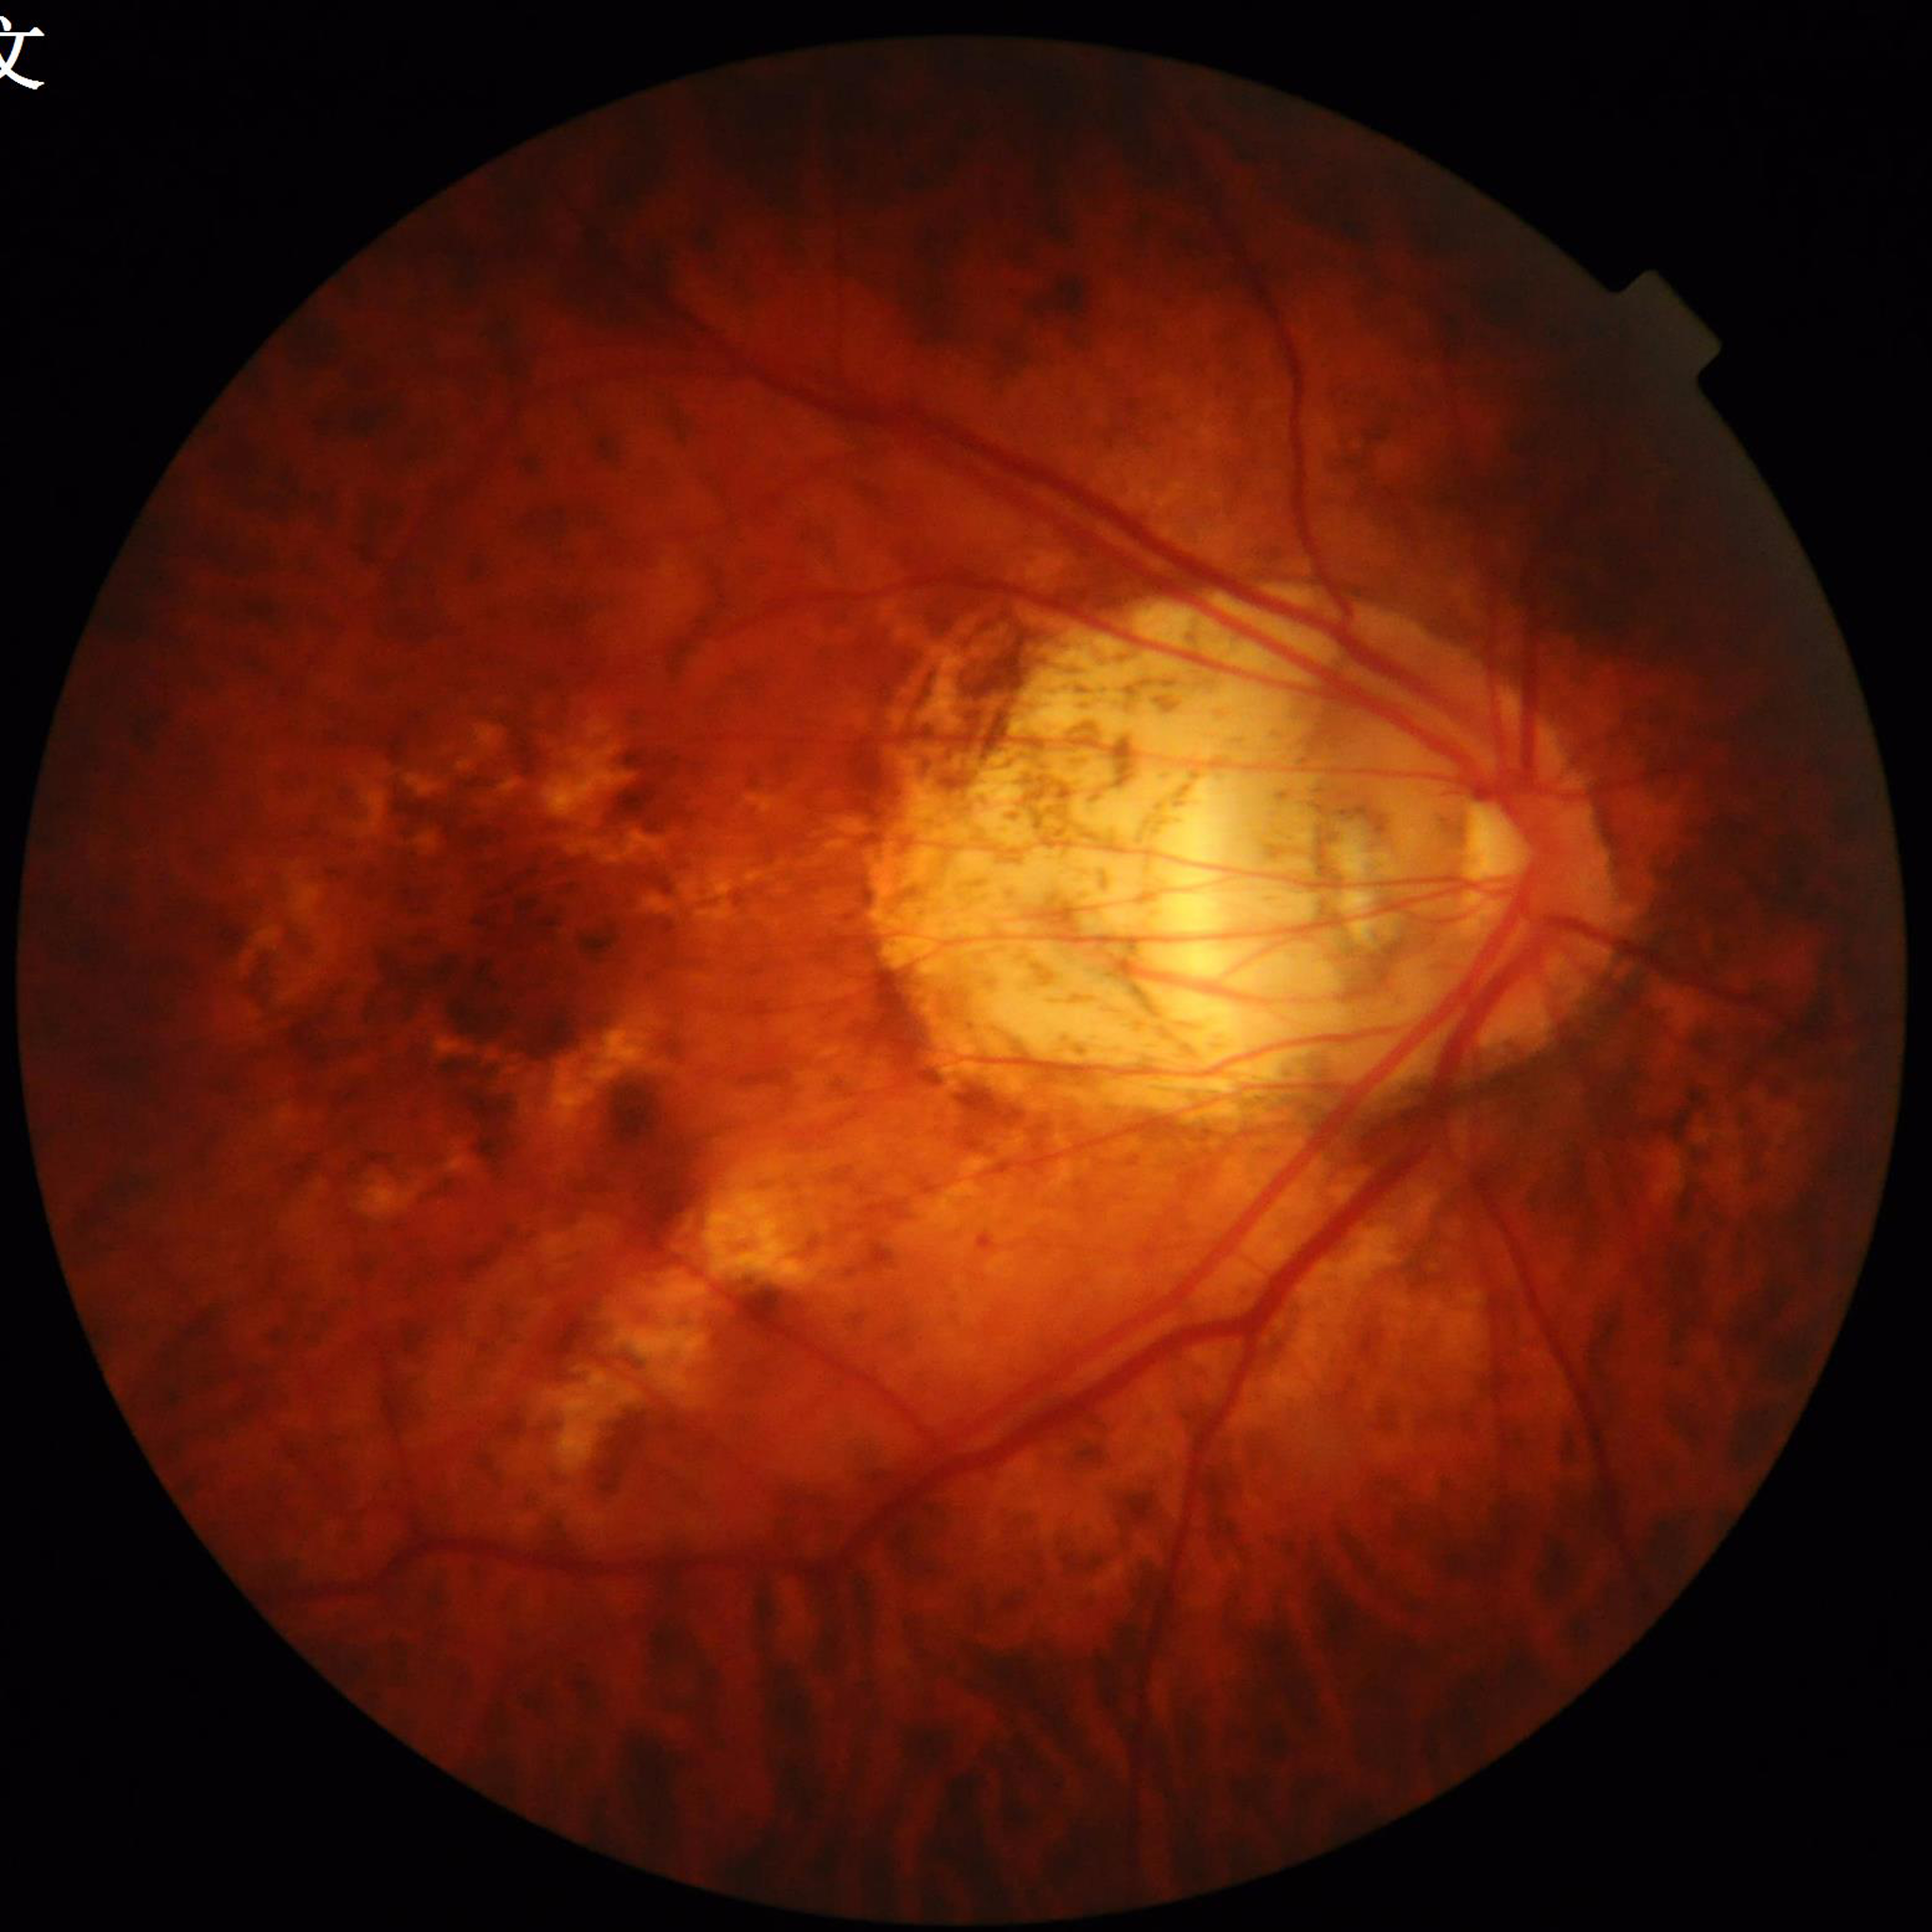

Quality: no quality issues identified.
Color fundus photo. Patient diagnosed with diabetic retinopathy.